45-degree field of view — 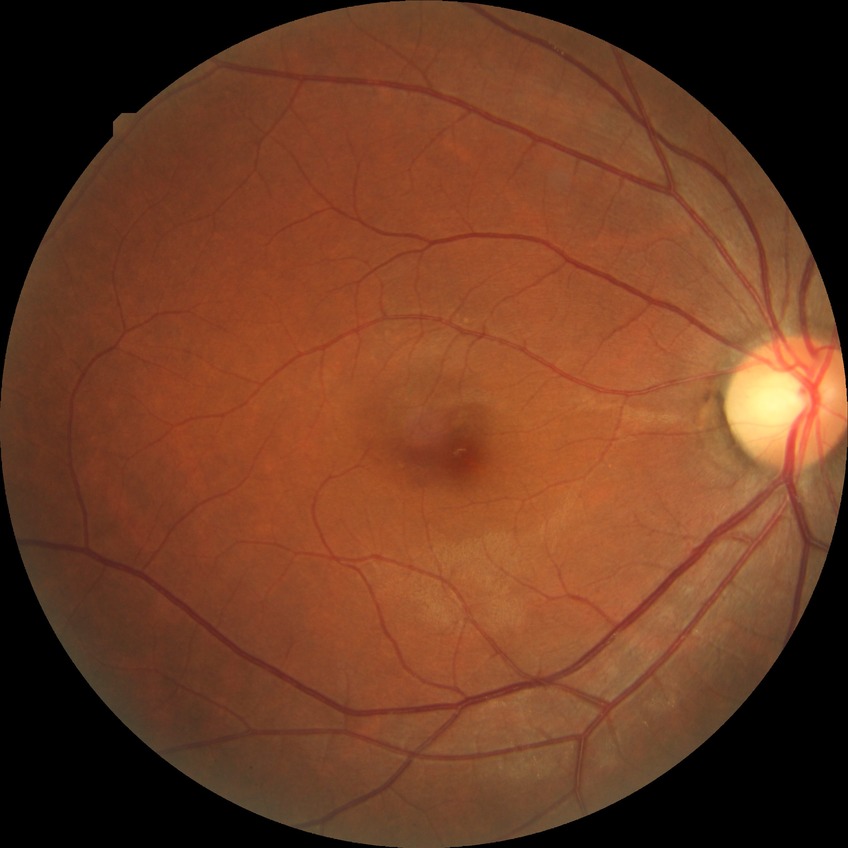
Diabetic retinopathy (DR): no diabetic retinopathy (NDR).